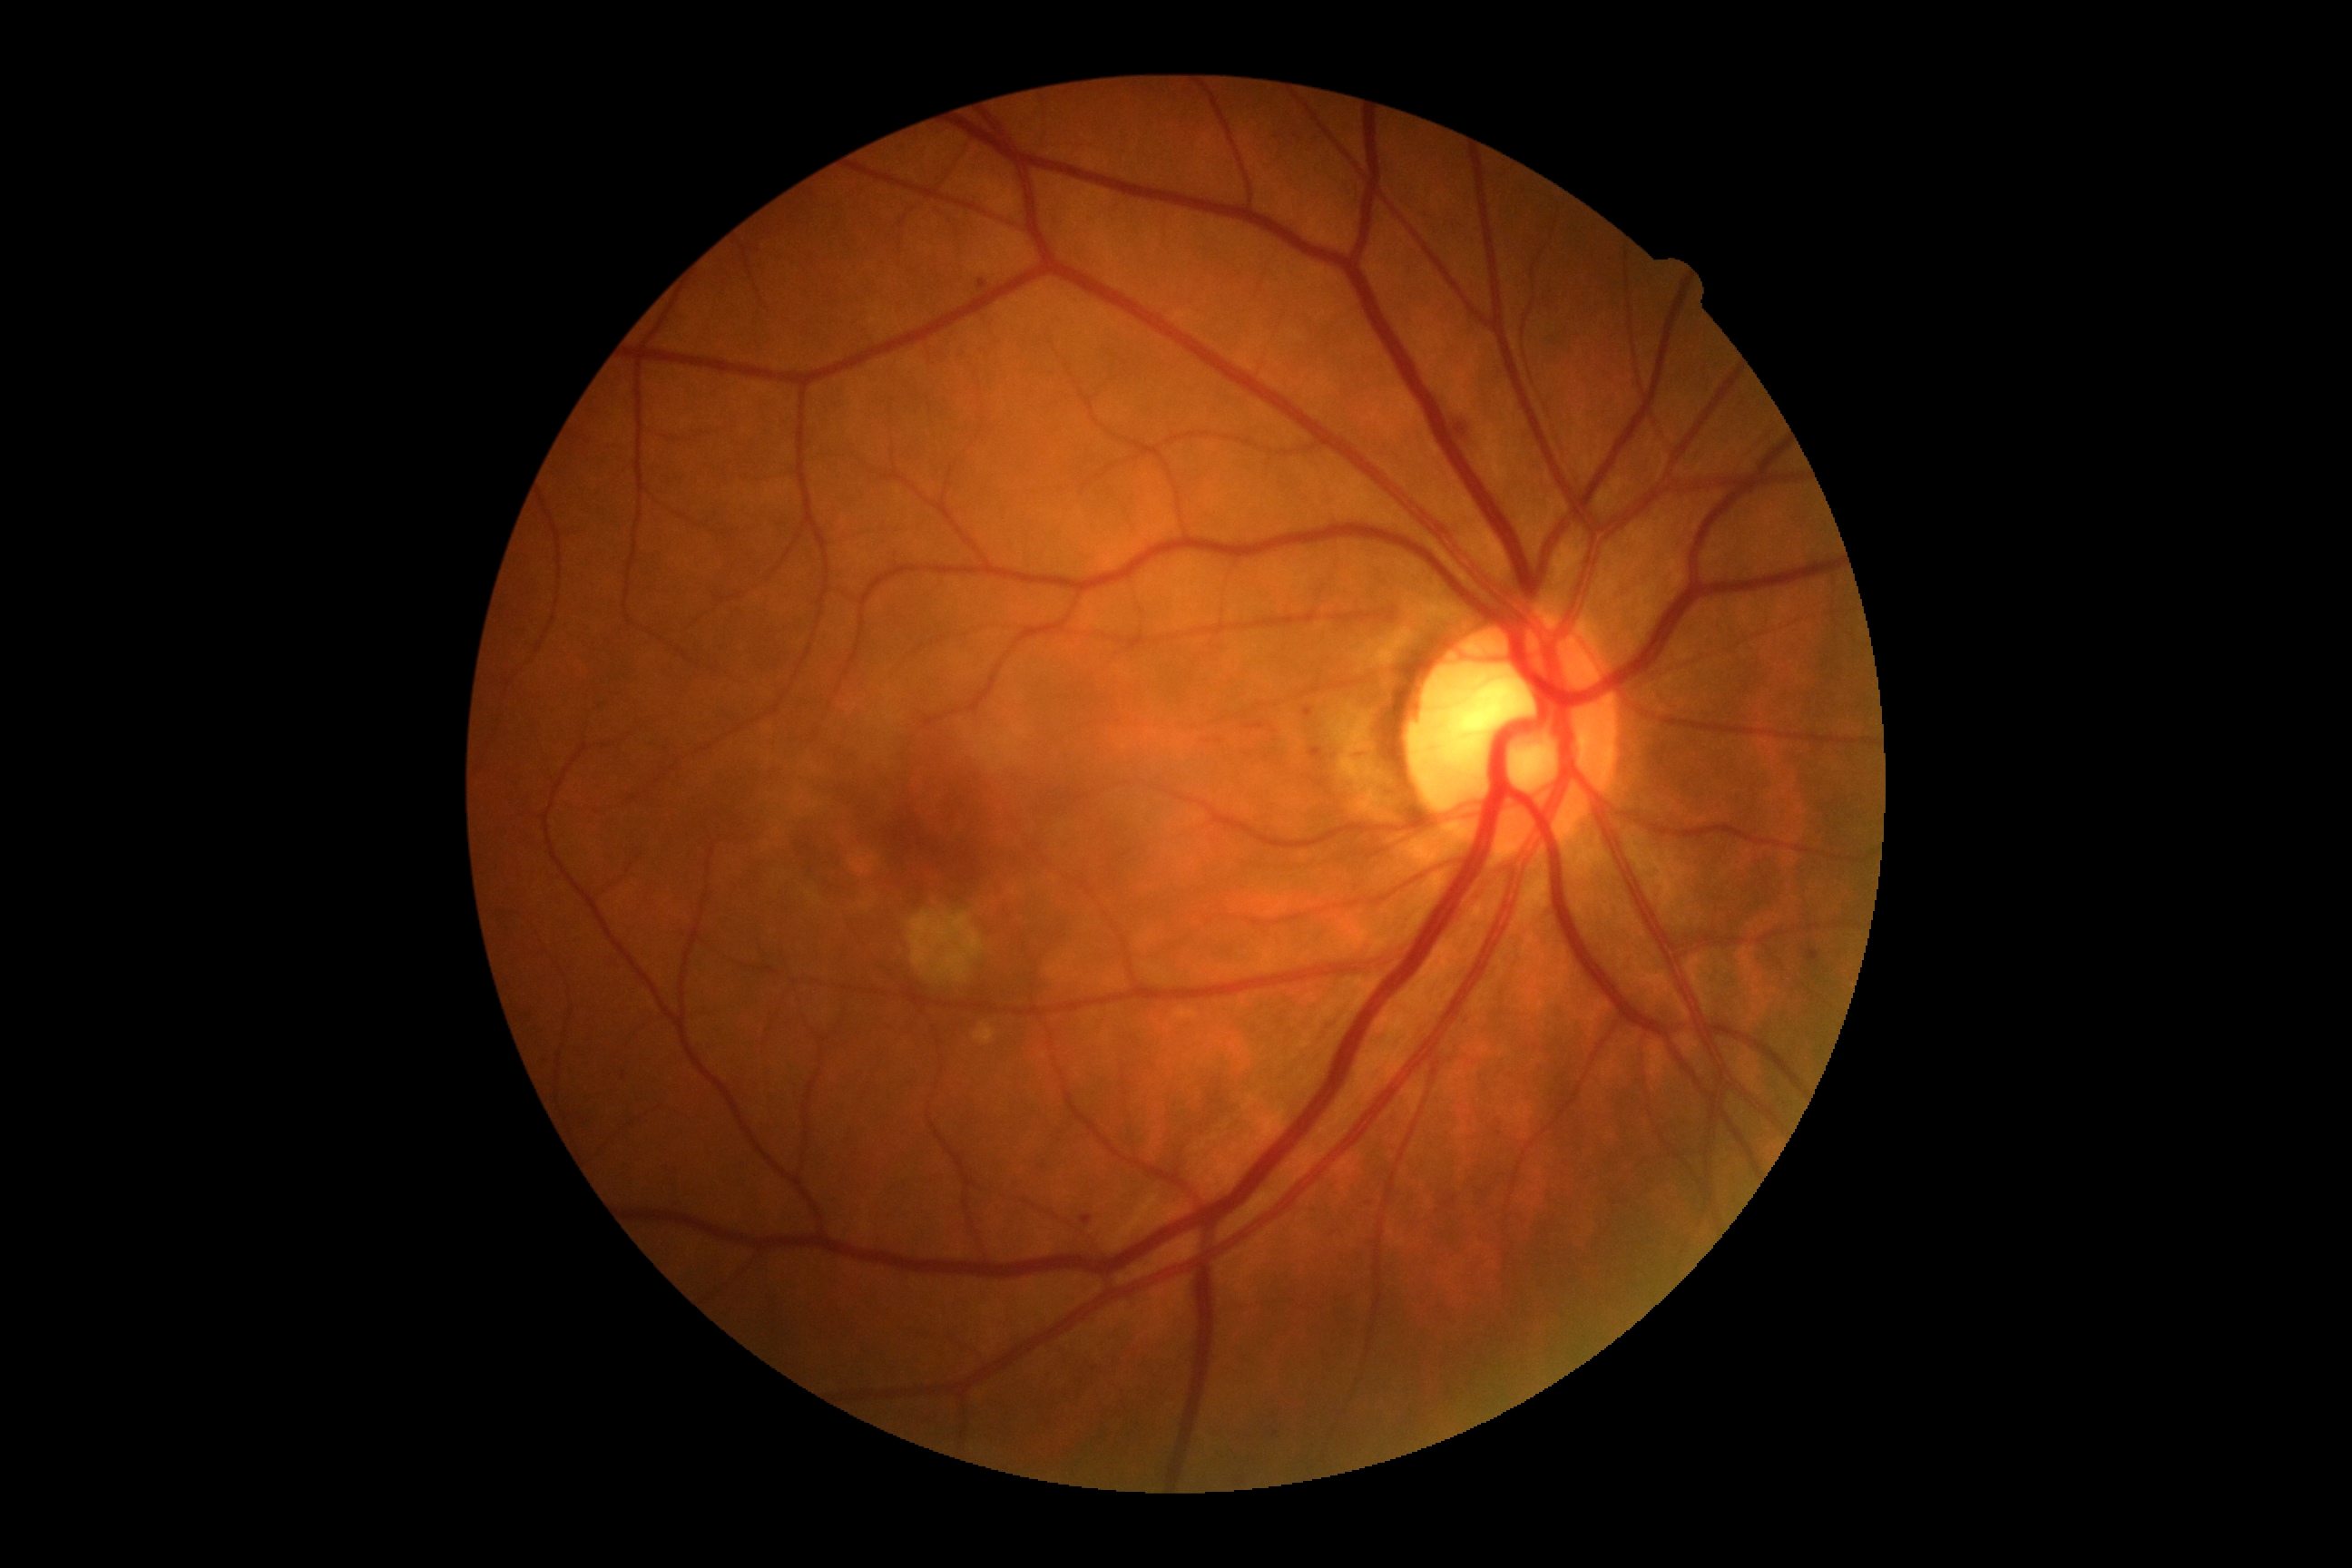

• DR grade — 2
• DR class — non-proliferative diabetic retinopathy